Modified Davis grading.
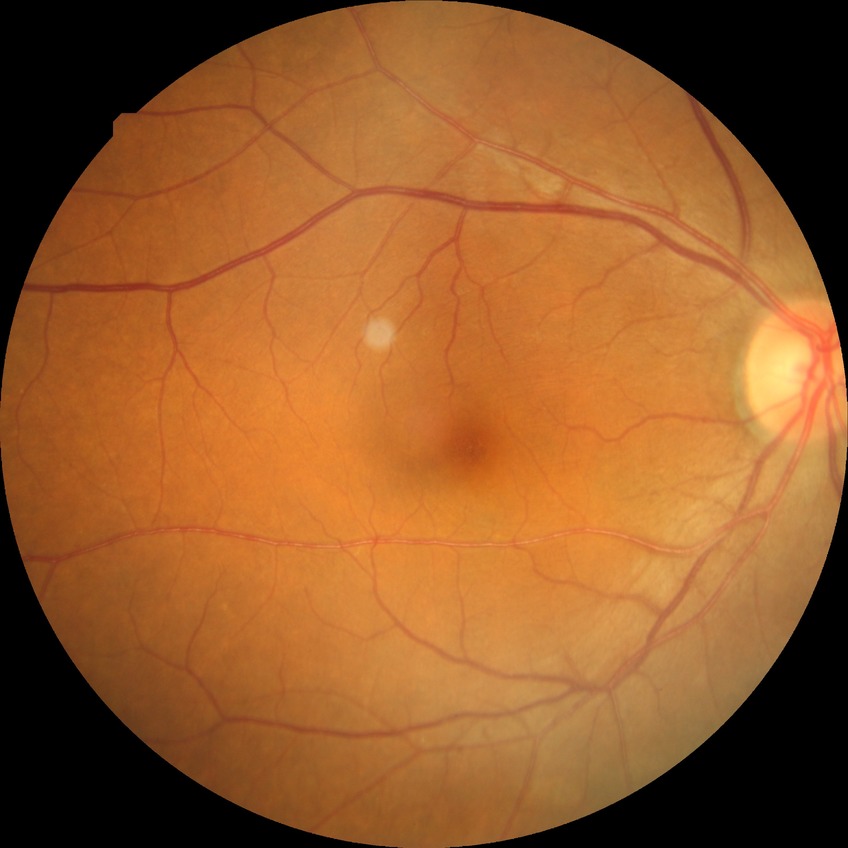
Diabetic retinopathy (DR): NDR (no diabetic retinopathy).